Optic nerve head photograph · captured on a Topcon TRC retinal camera.
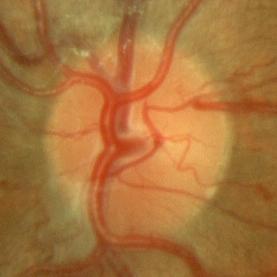 Q: Glaucoma assessment?
A: No evidence of glaucoma.